2089x1764: 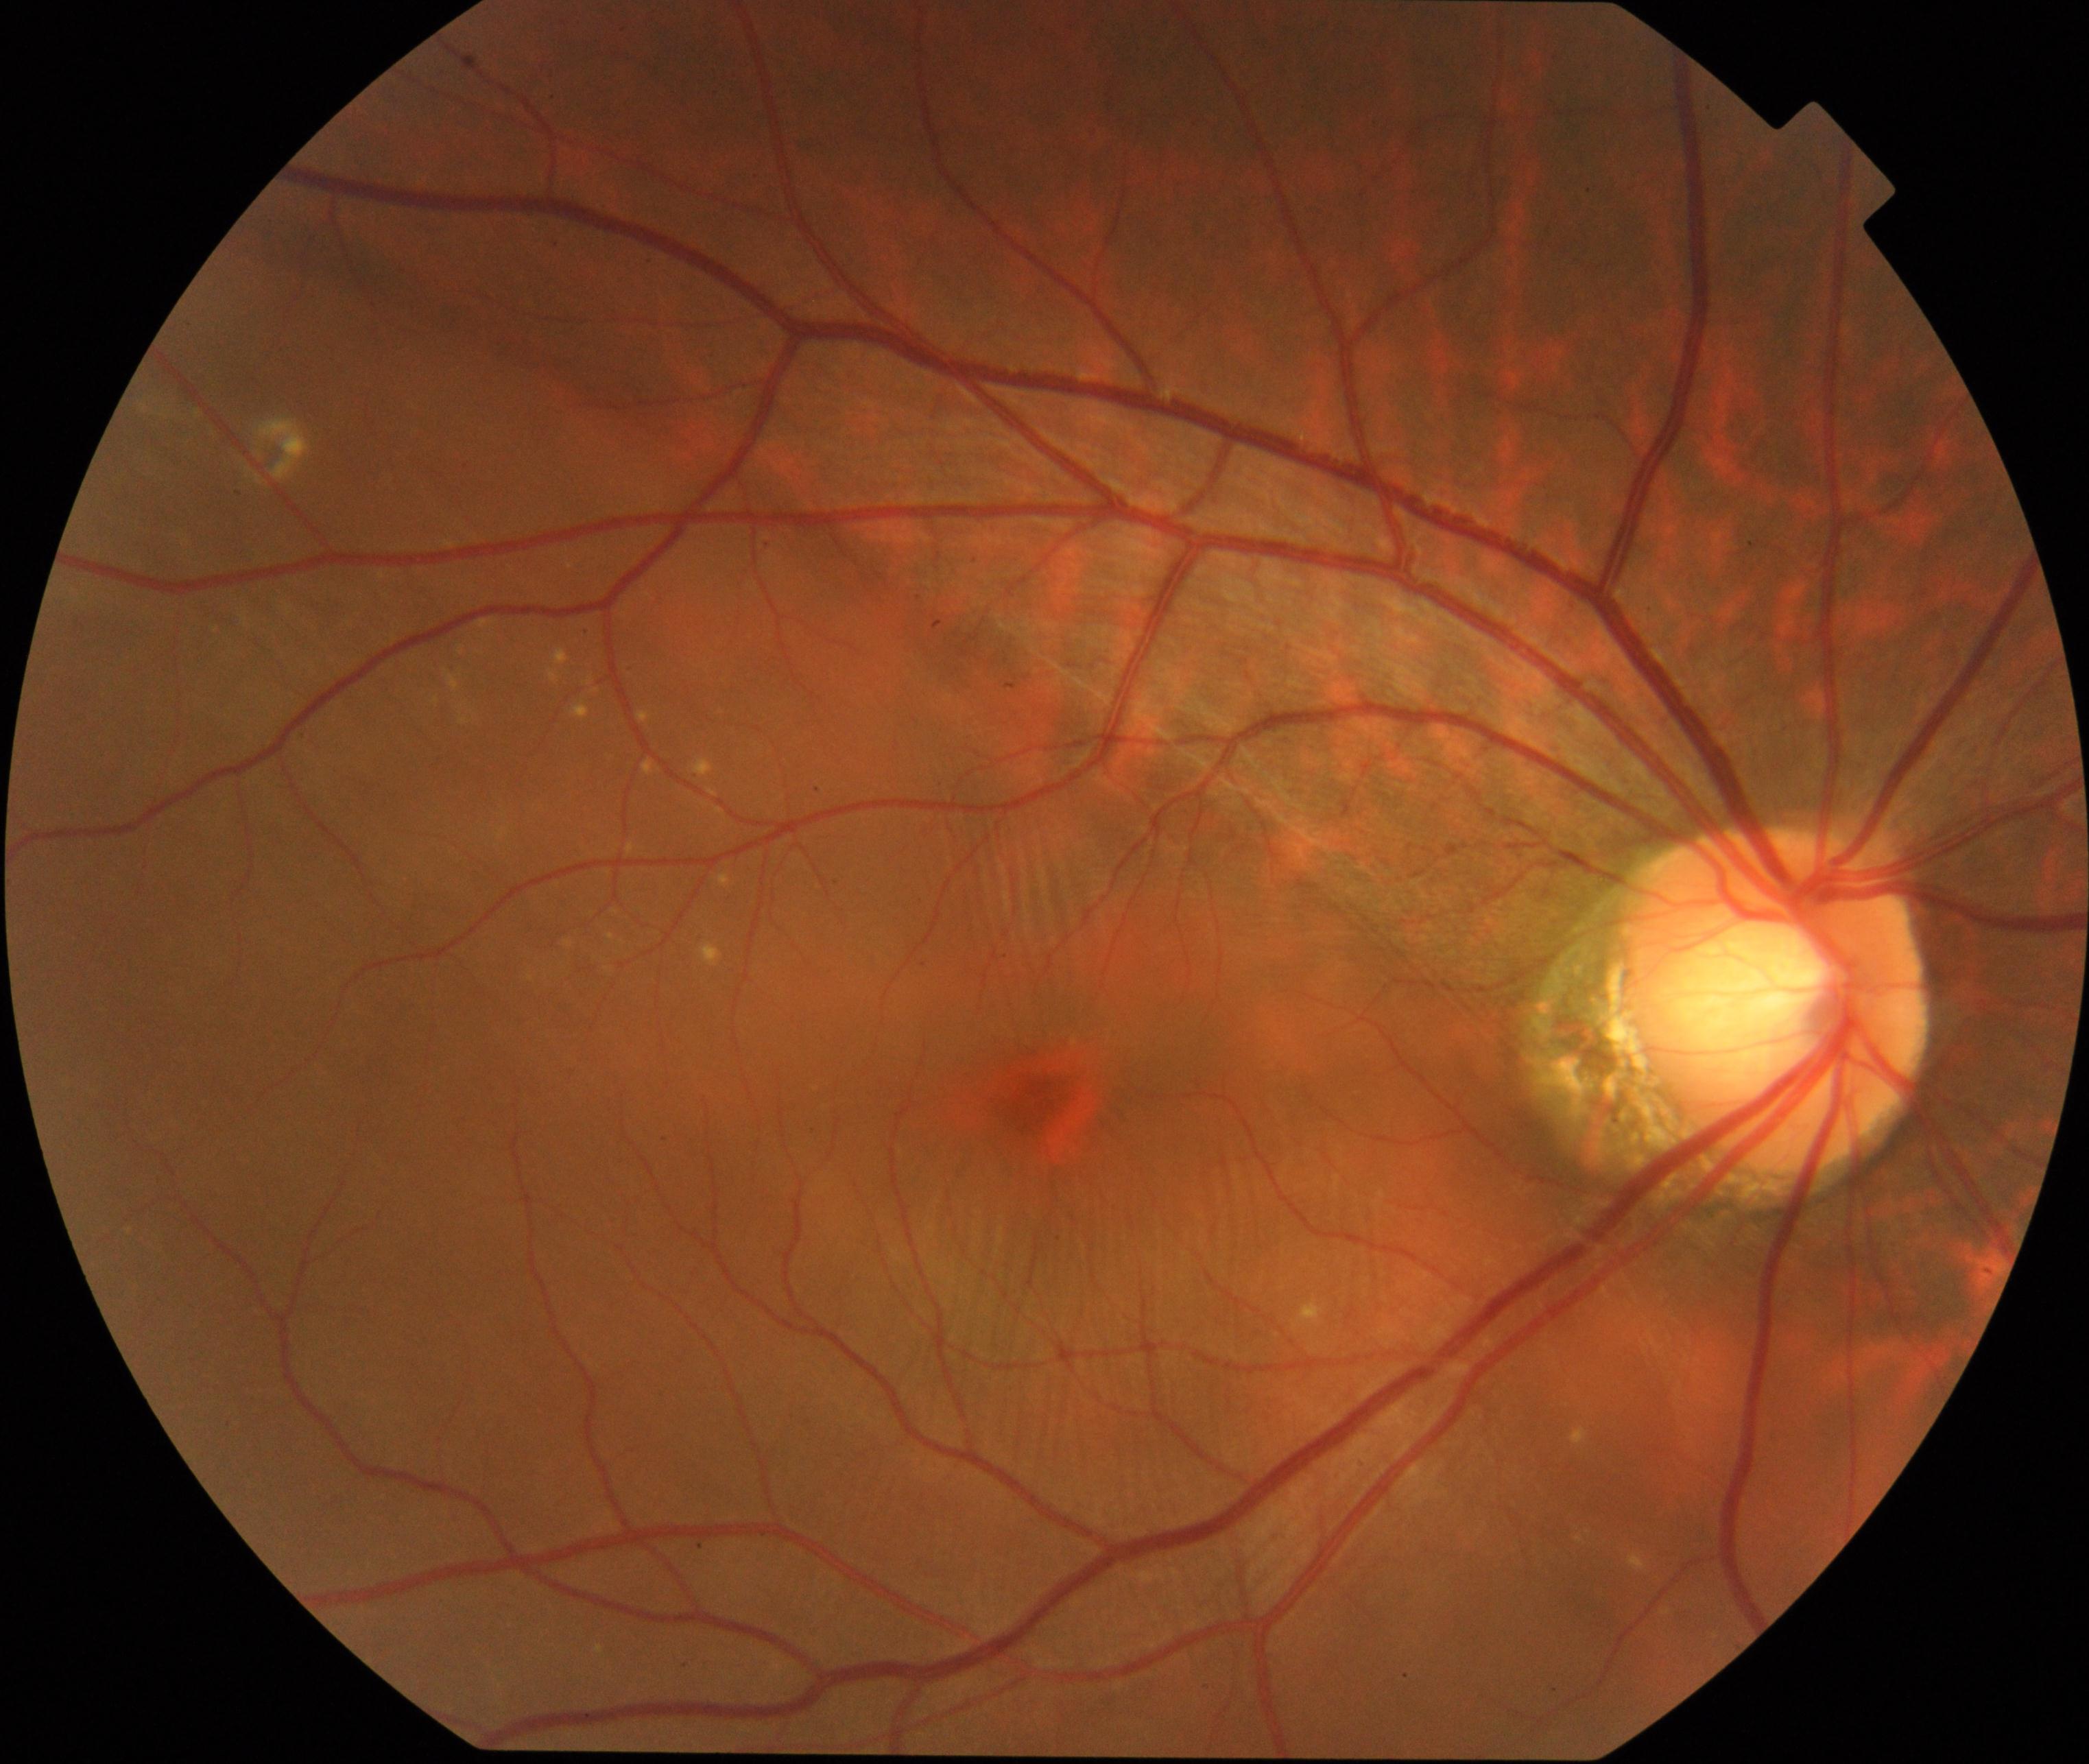

Findings: rhegmatogenous retinal detachment.